Macula-centered field; captured on a Topcon TRC-NW8 fundus camera — 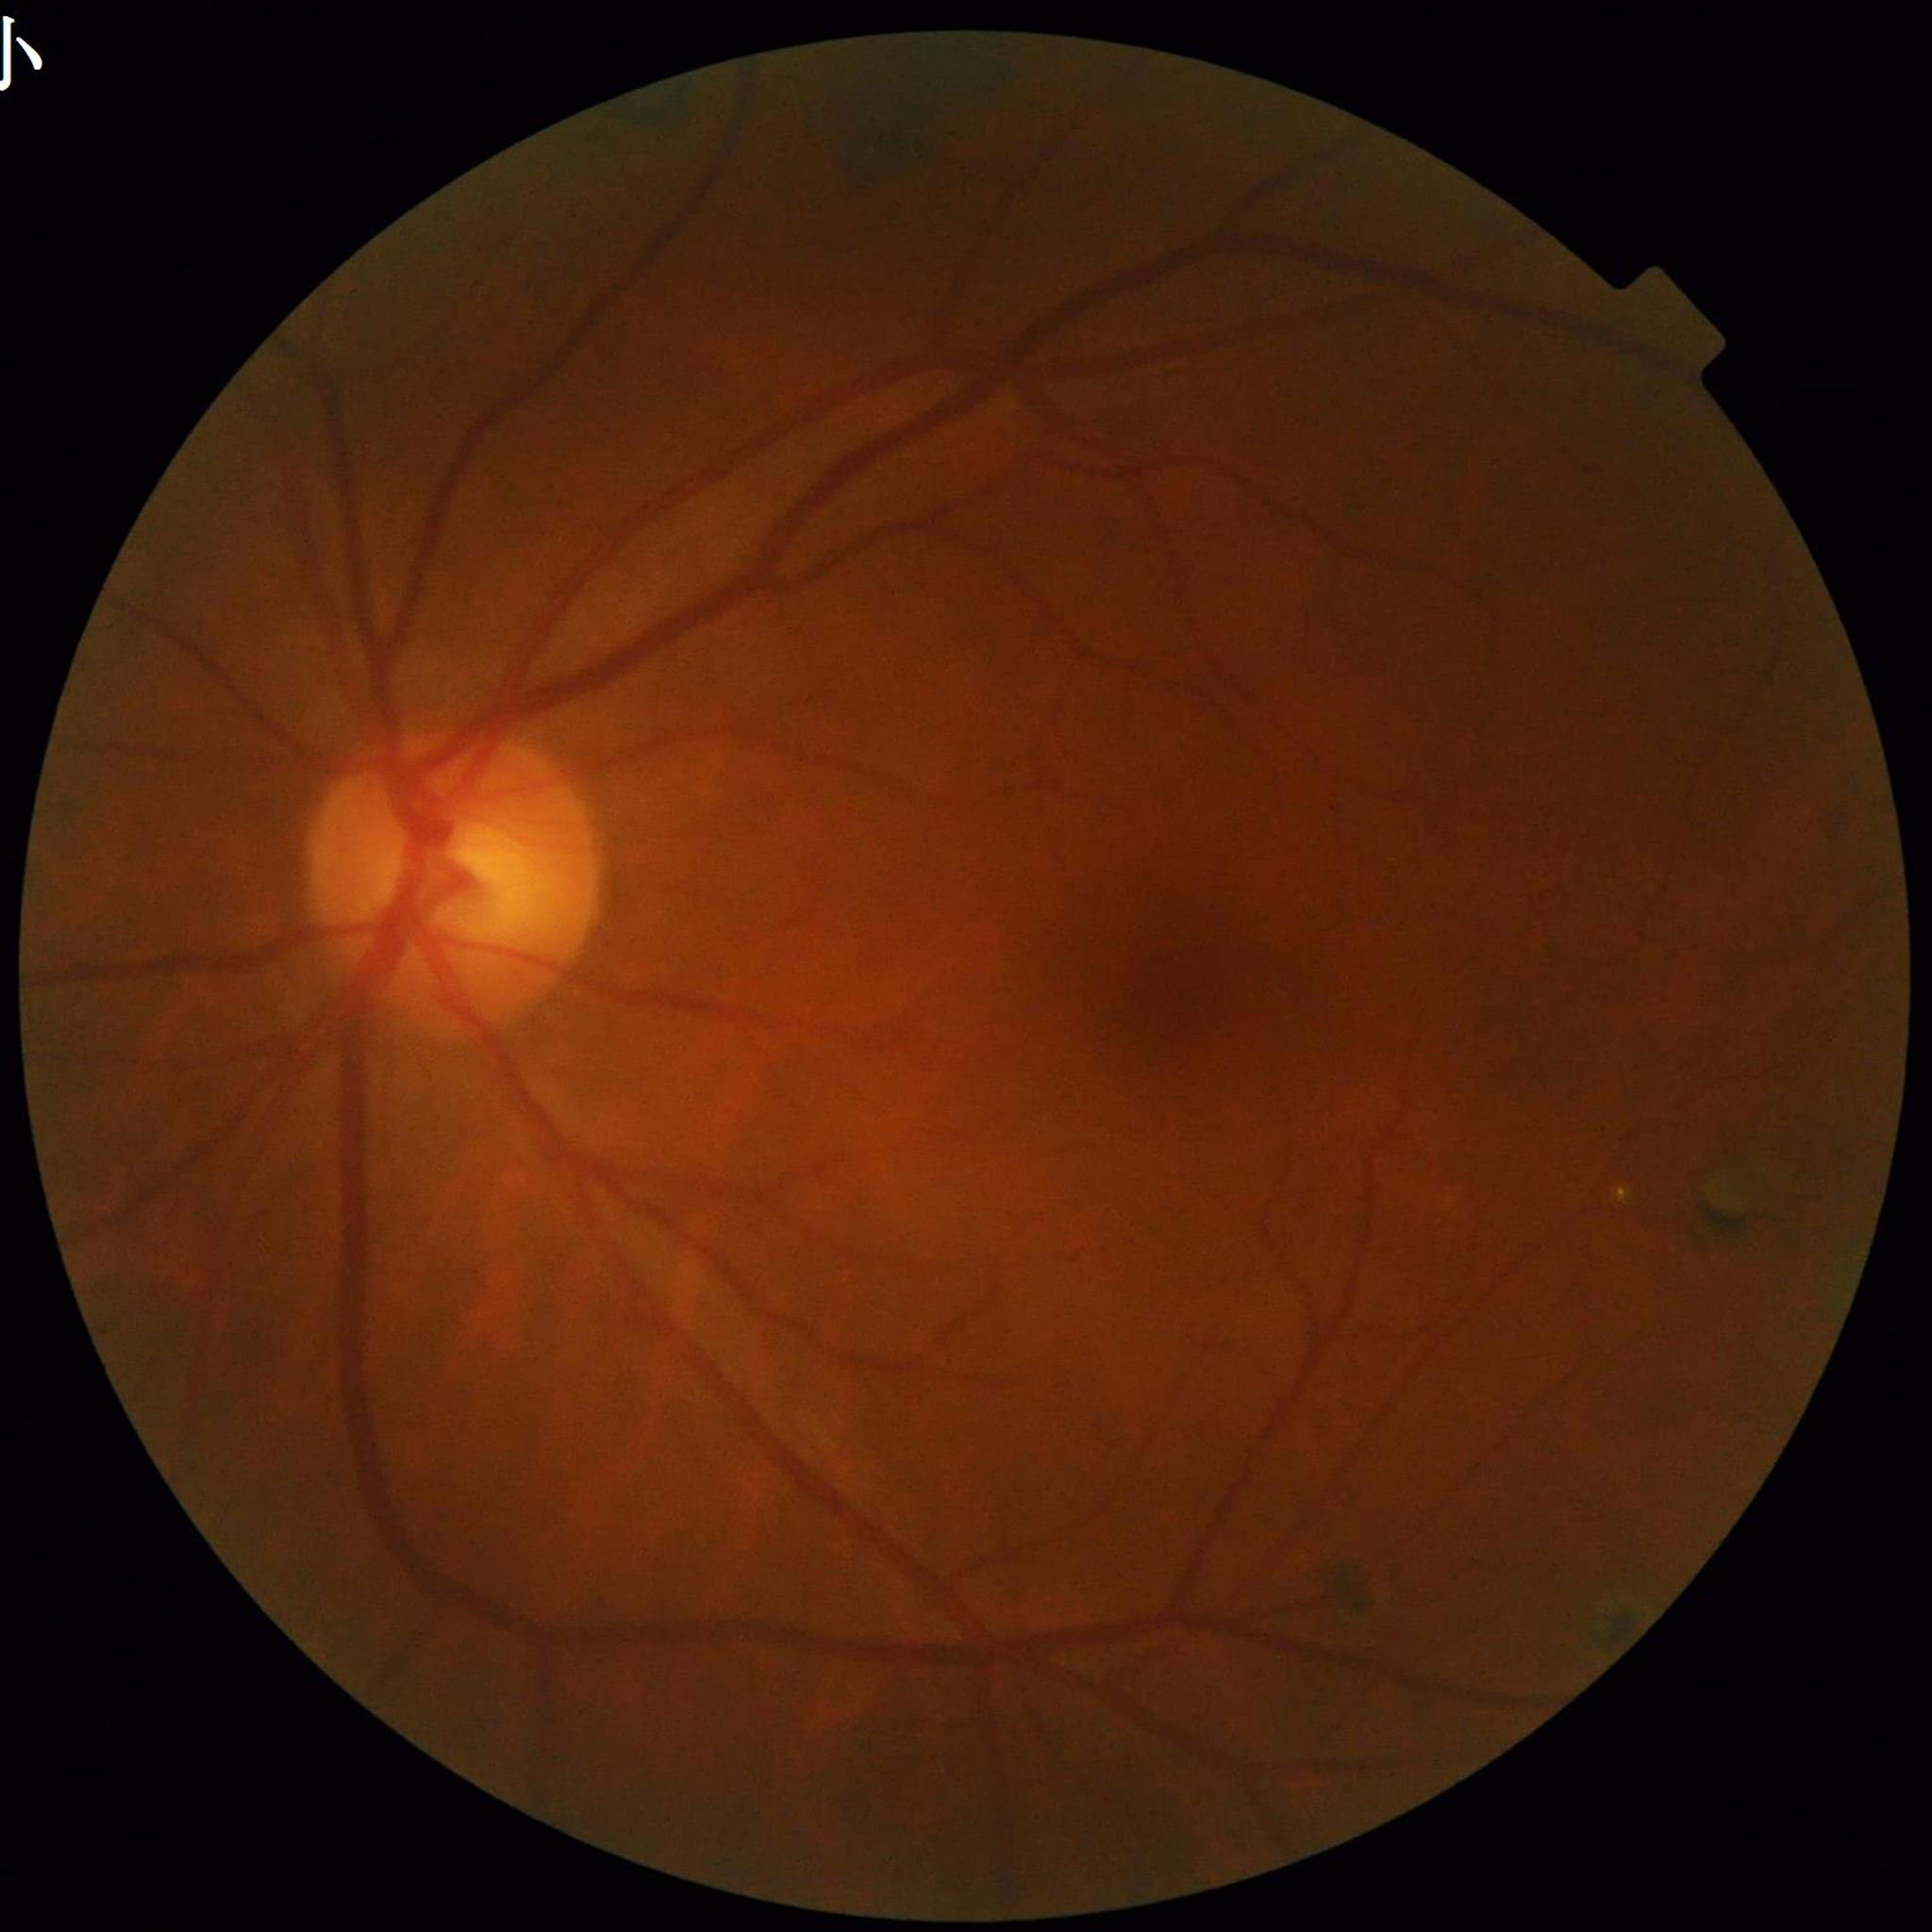

Clinical diagnosis = diabetic retinopathy.